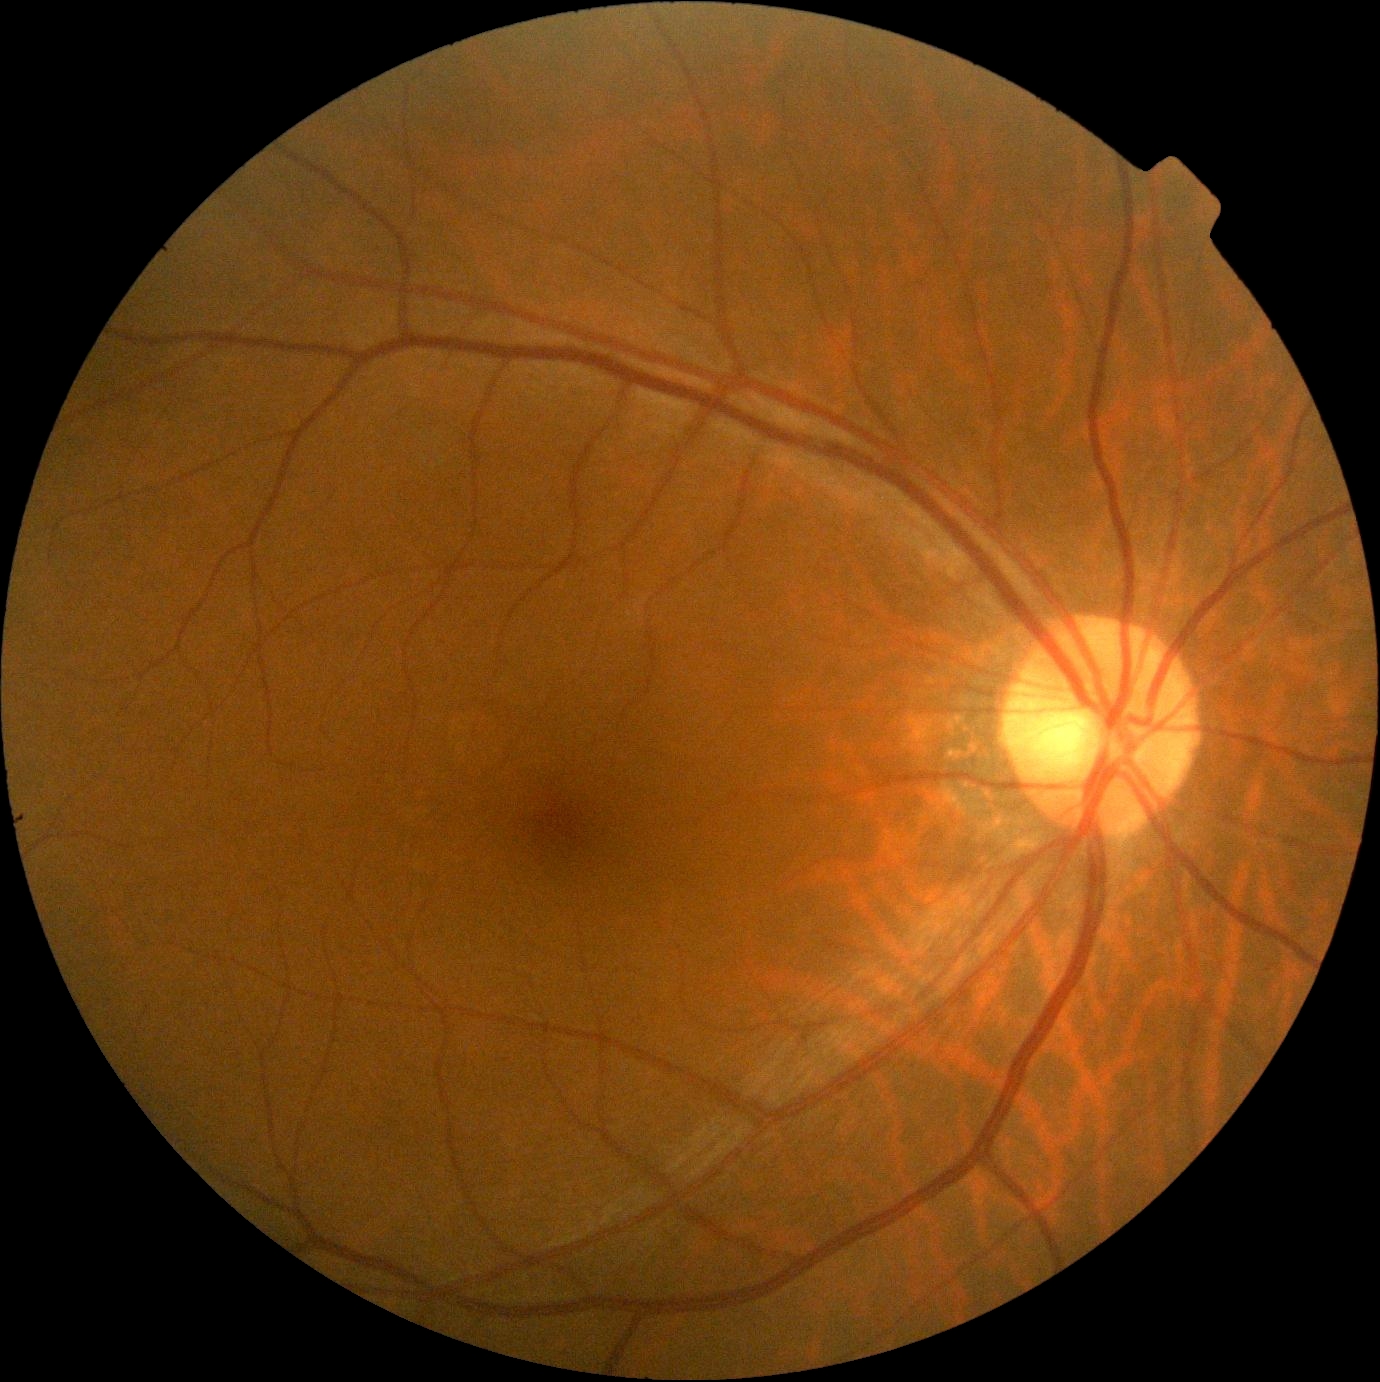 DR: 0.